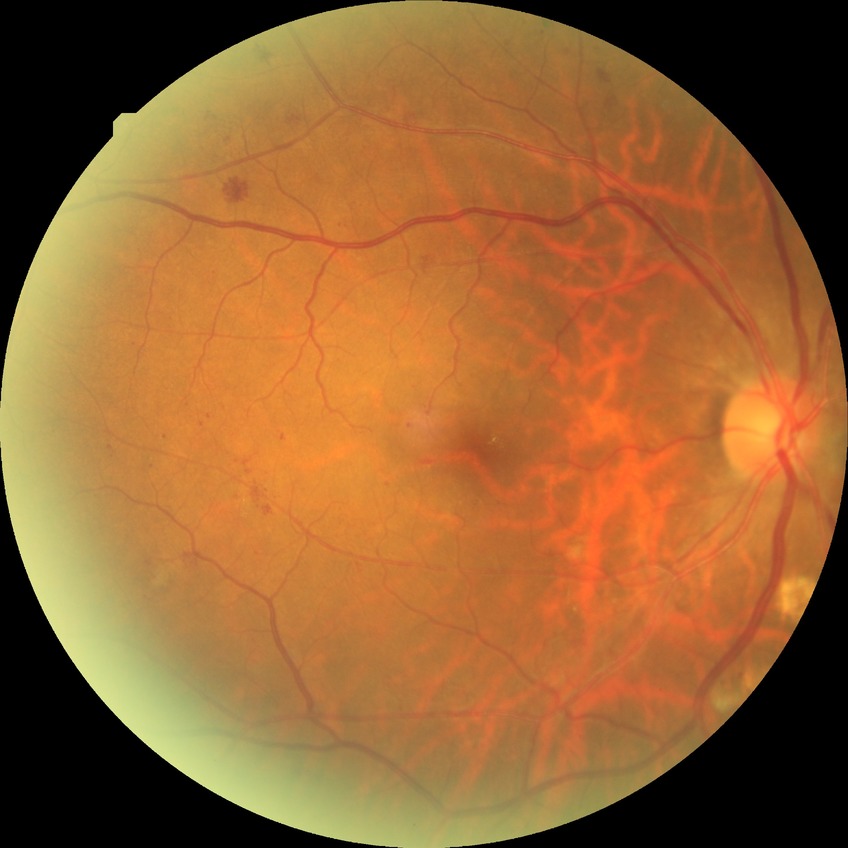
DR grade=PPDR.